1440 x 1080 pixels; infant wide-field retinal image — 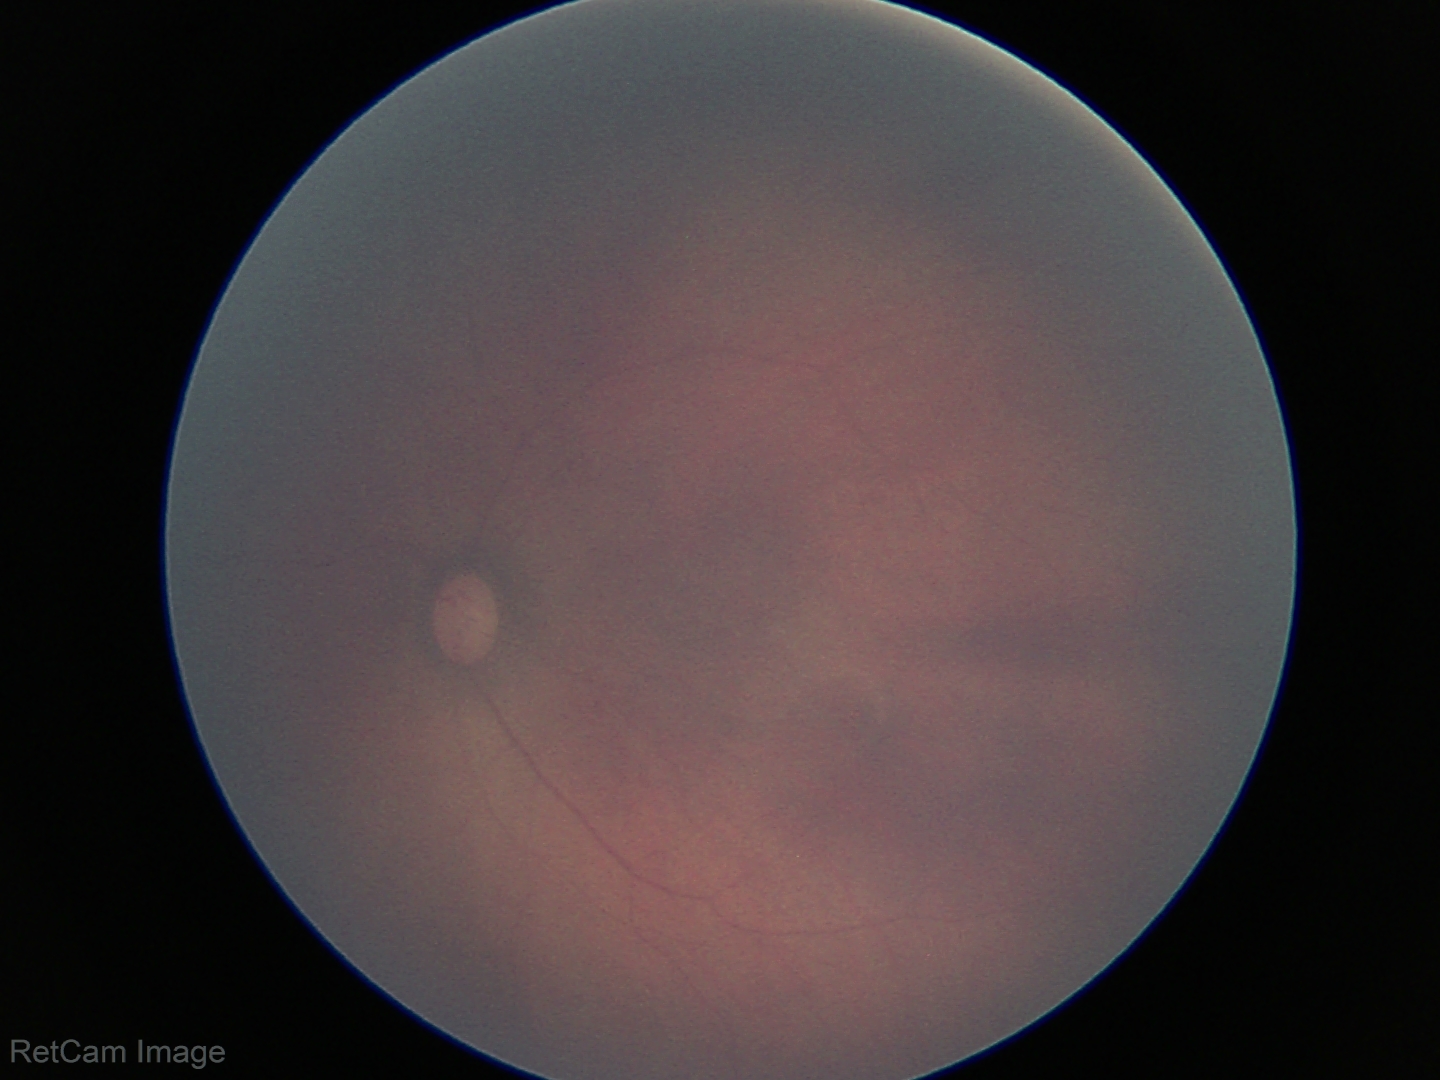 Q: What is the screening diagnosis?
A: no abnormal retinal findings